512x512px; CFP
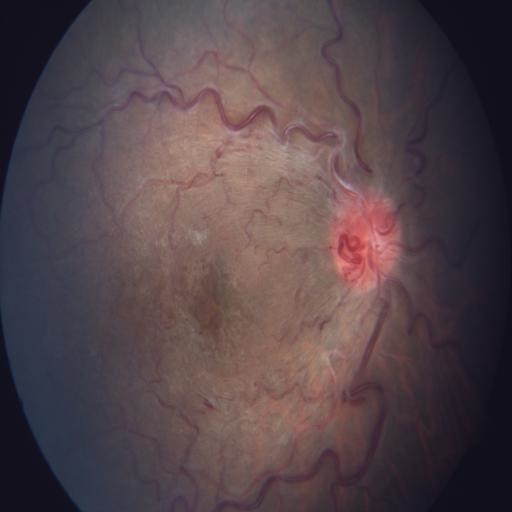 Findings: tortuous vessels (TV), central retinal vein occlusion (CRVO).